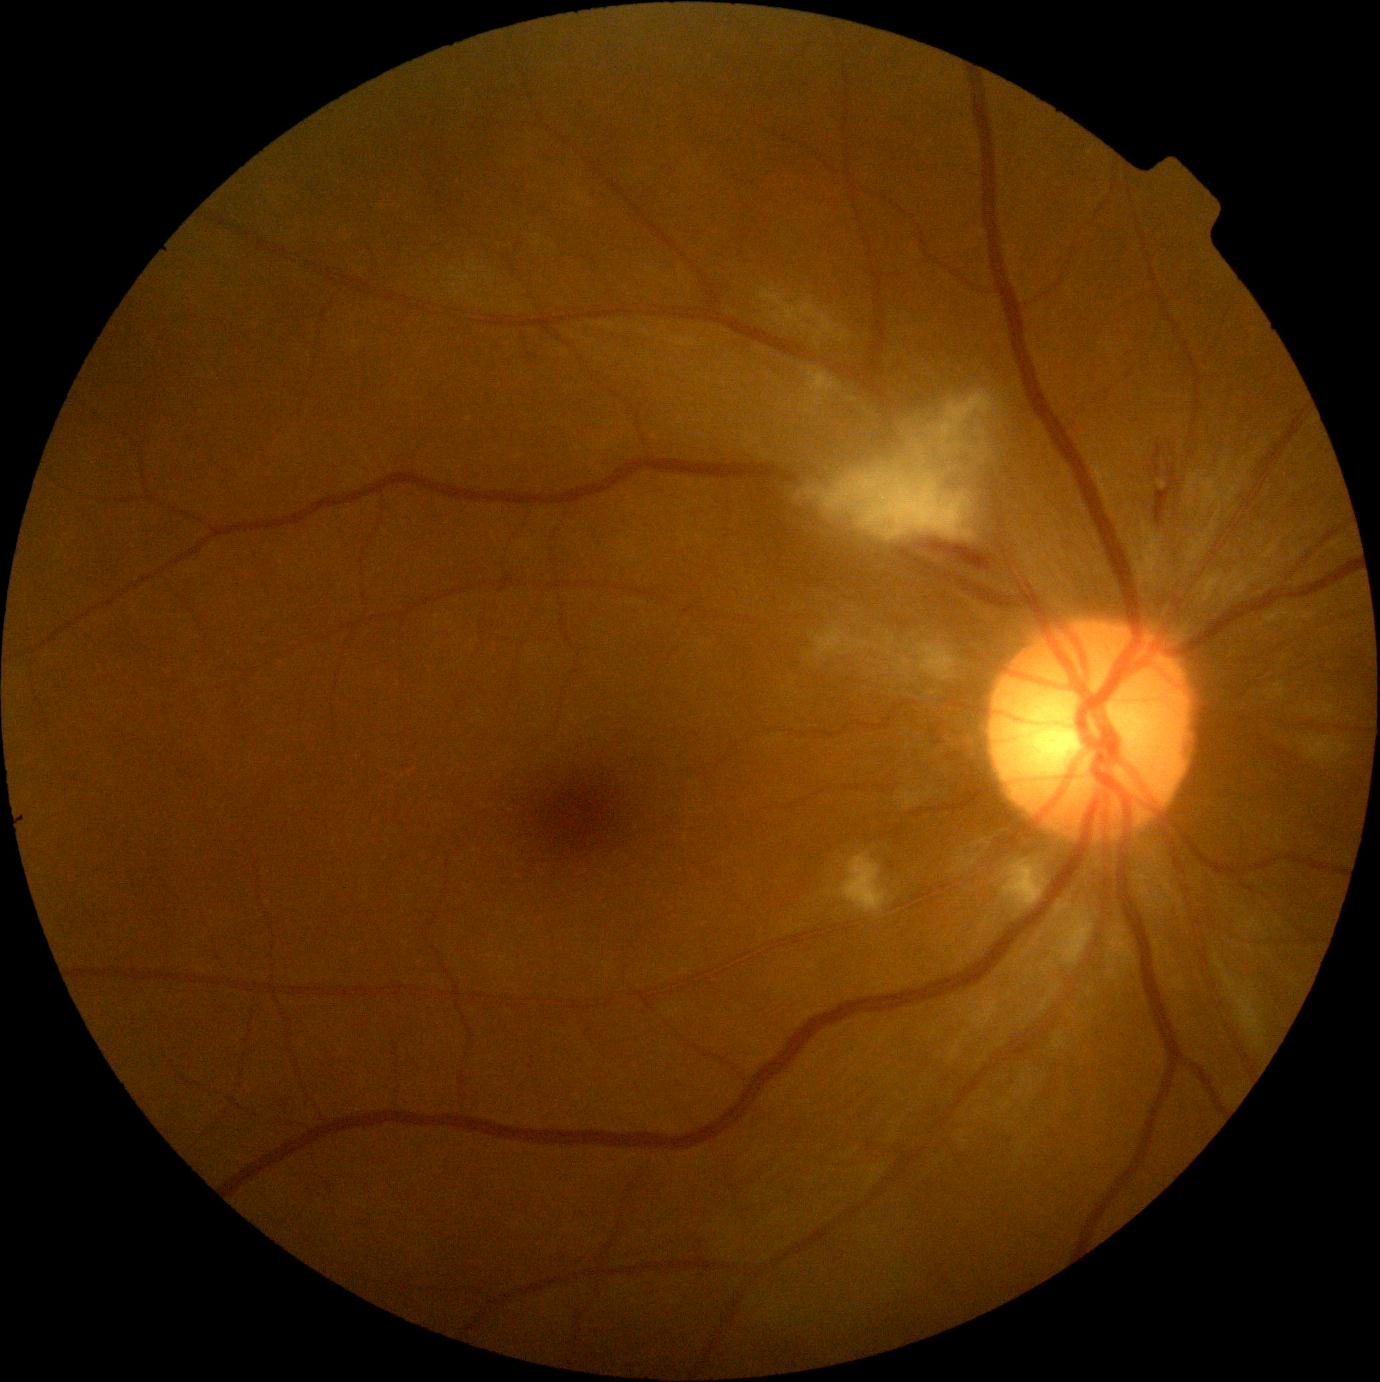
Diabetic retinopathy severity: moderate non-proliferative diabetic retinopathy (grade 2) — more than just microaneurysms but less than severe NPDR.